Color fundus photograph: 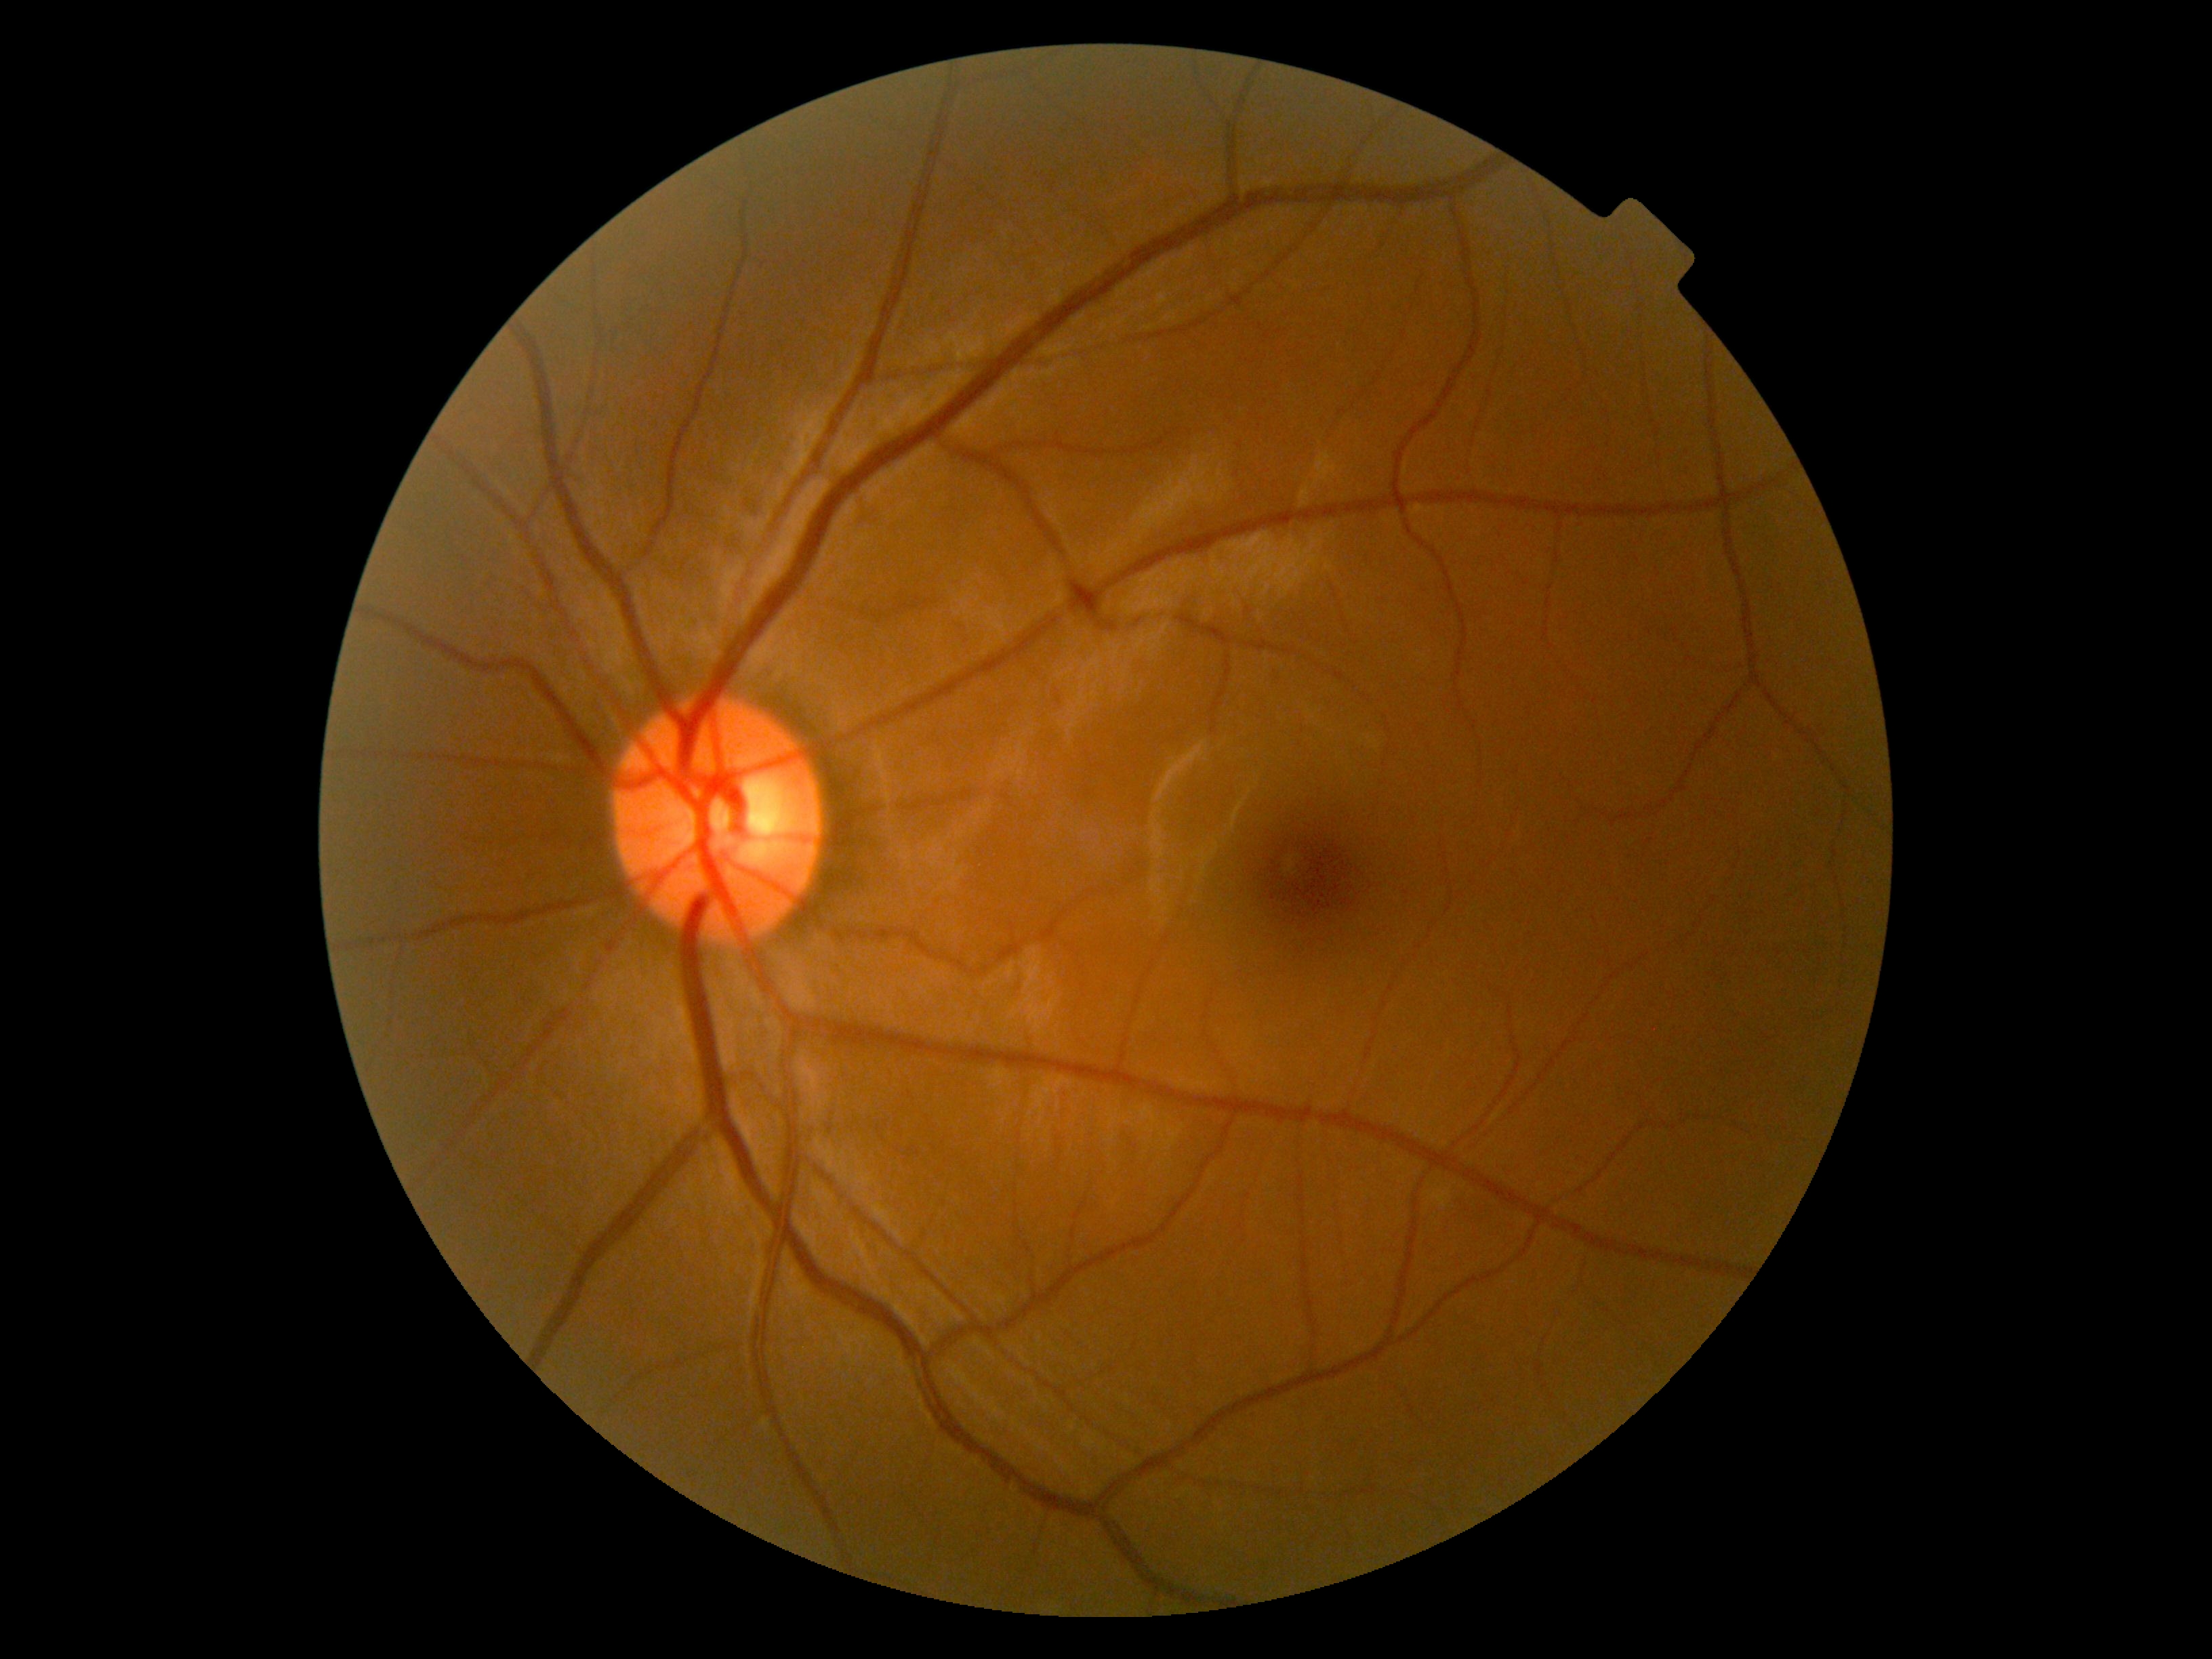 DR stage: 0, DR impression: negative for DR.